NIDEK AFC-230 fundus camera · no pharmacologic dilation
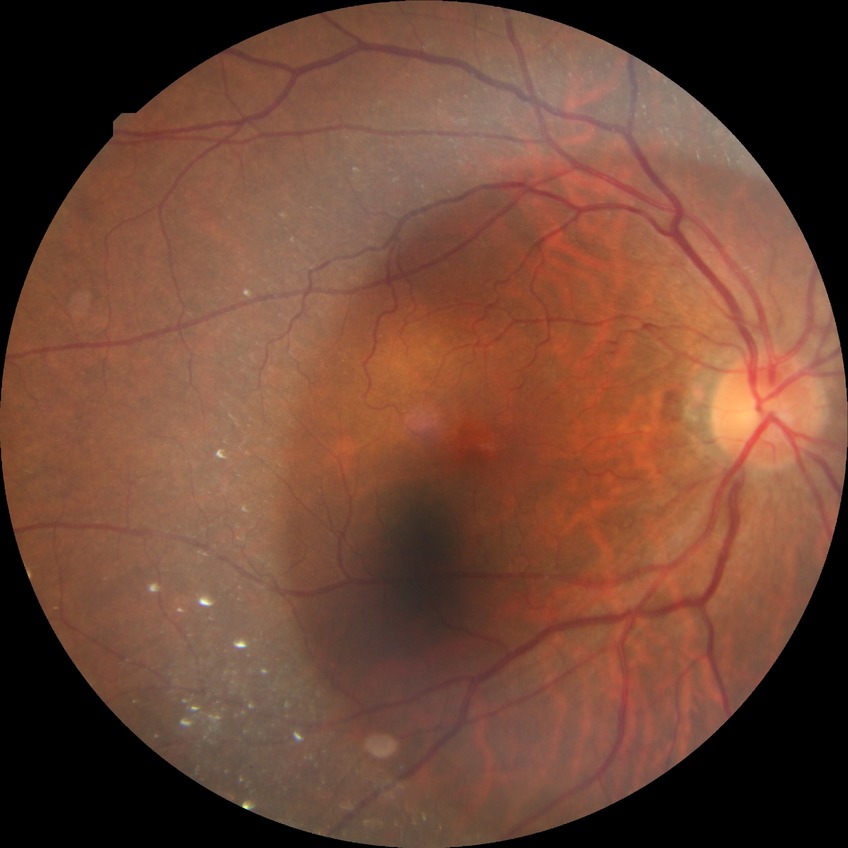 davis_grade: simple diabetic retinopathy
proliferative_class: non-proliferative diabetic retinopathy